Captured with the Phoenix ICON (100° field of view). Wide-field fundus image from infant ROP screening. Image size 1240x1240: 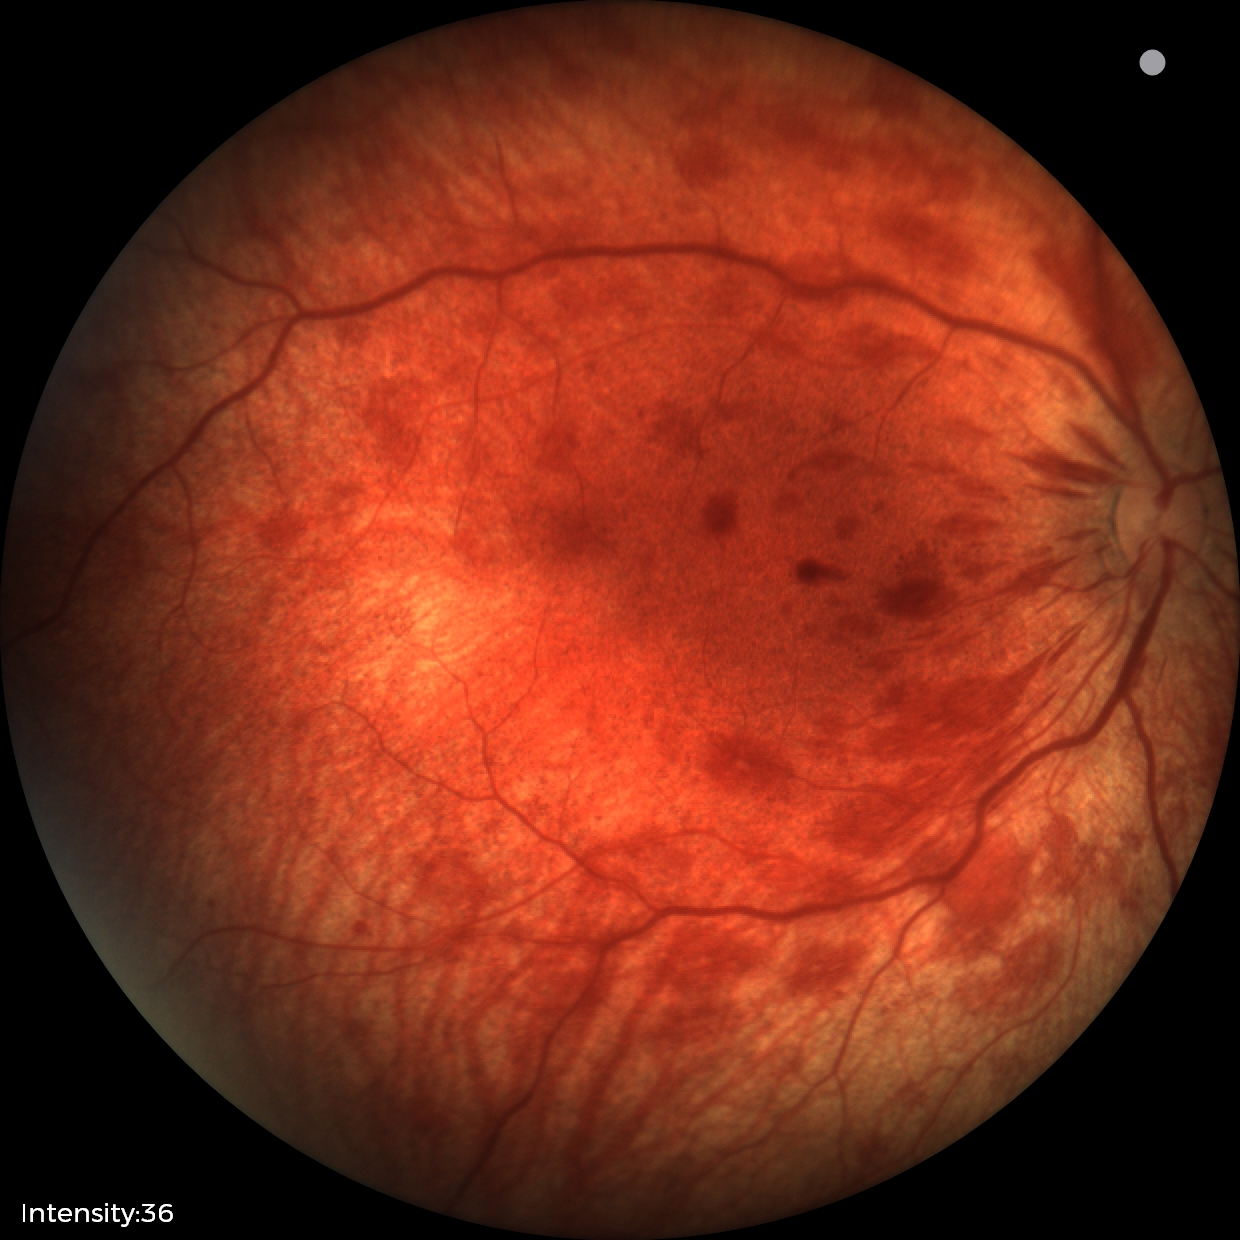

Assessment = retinal hemorrhages.